Color fundus photograph — 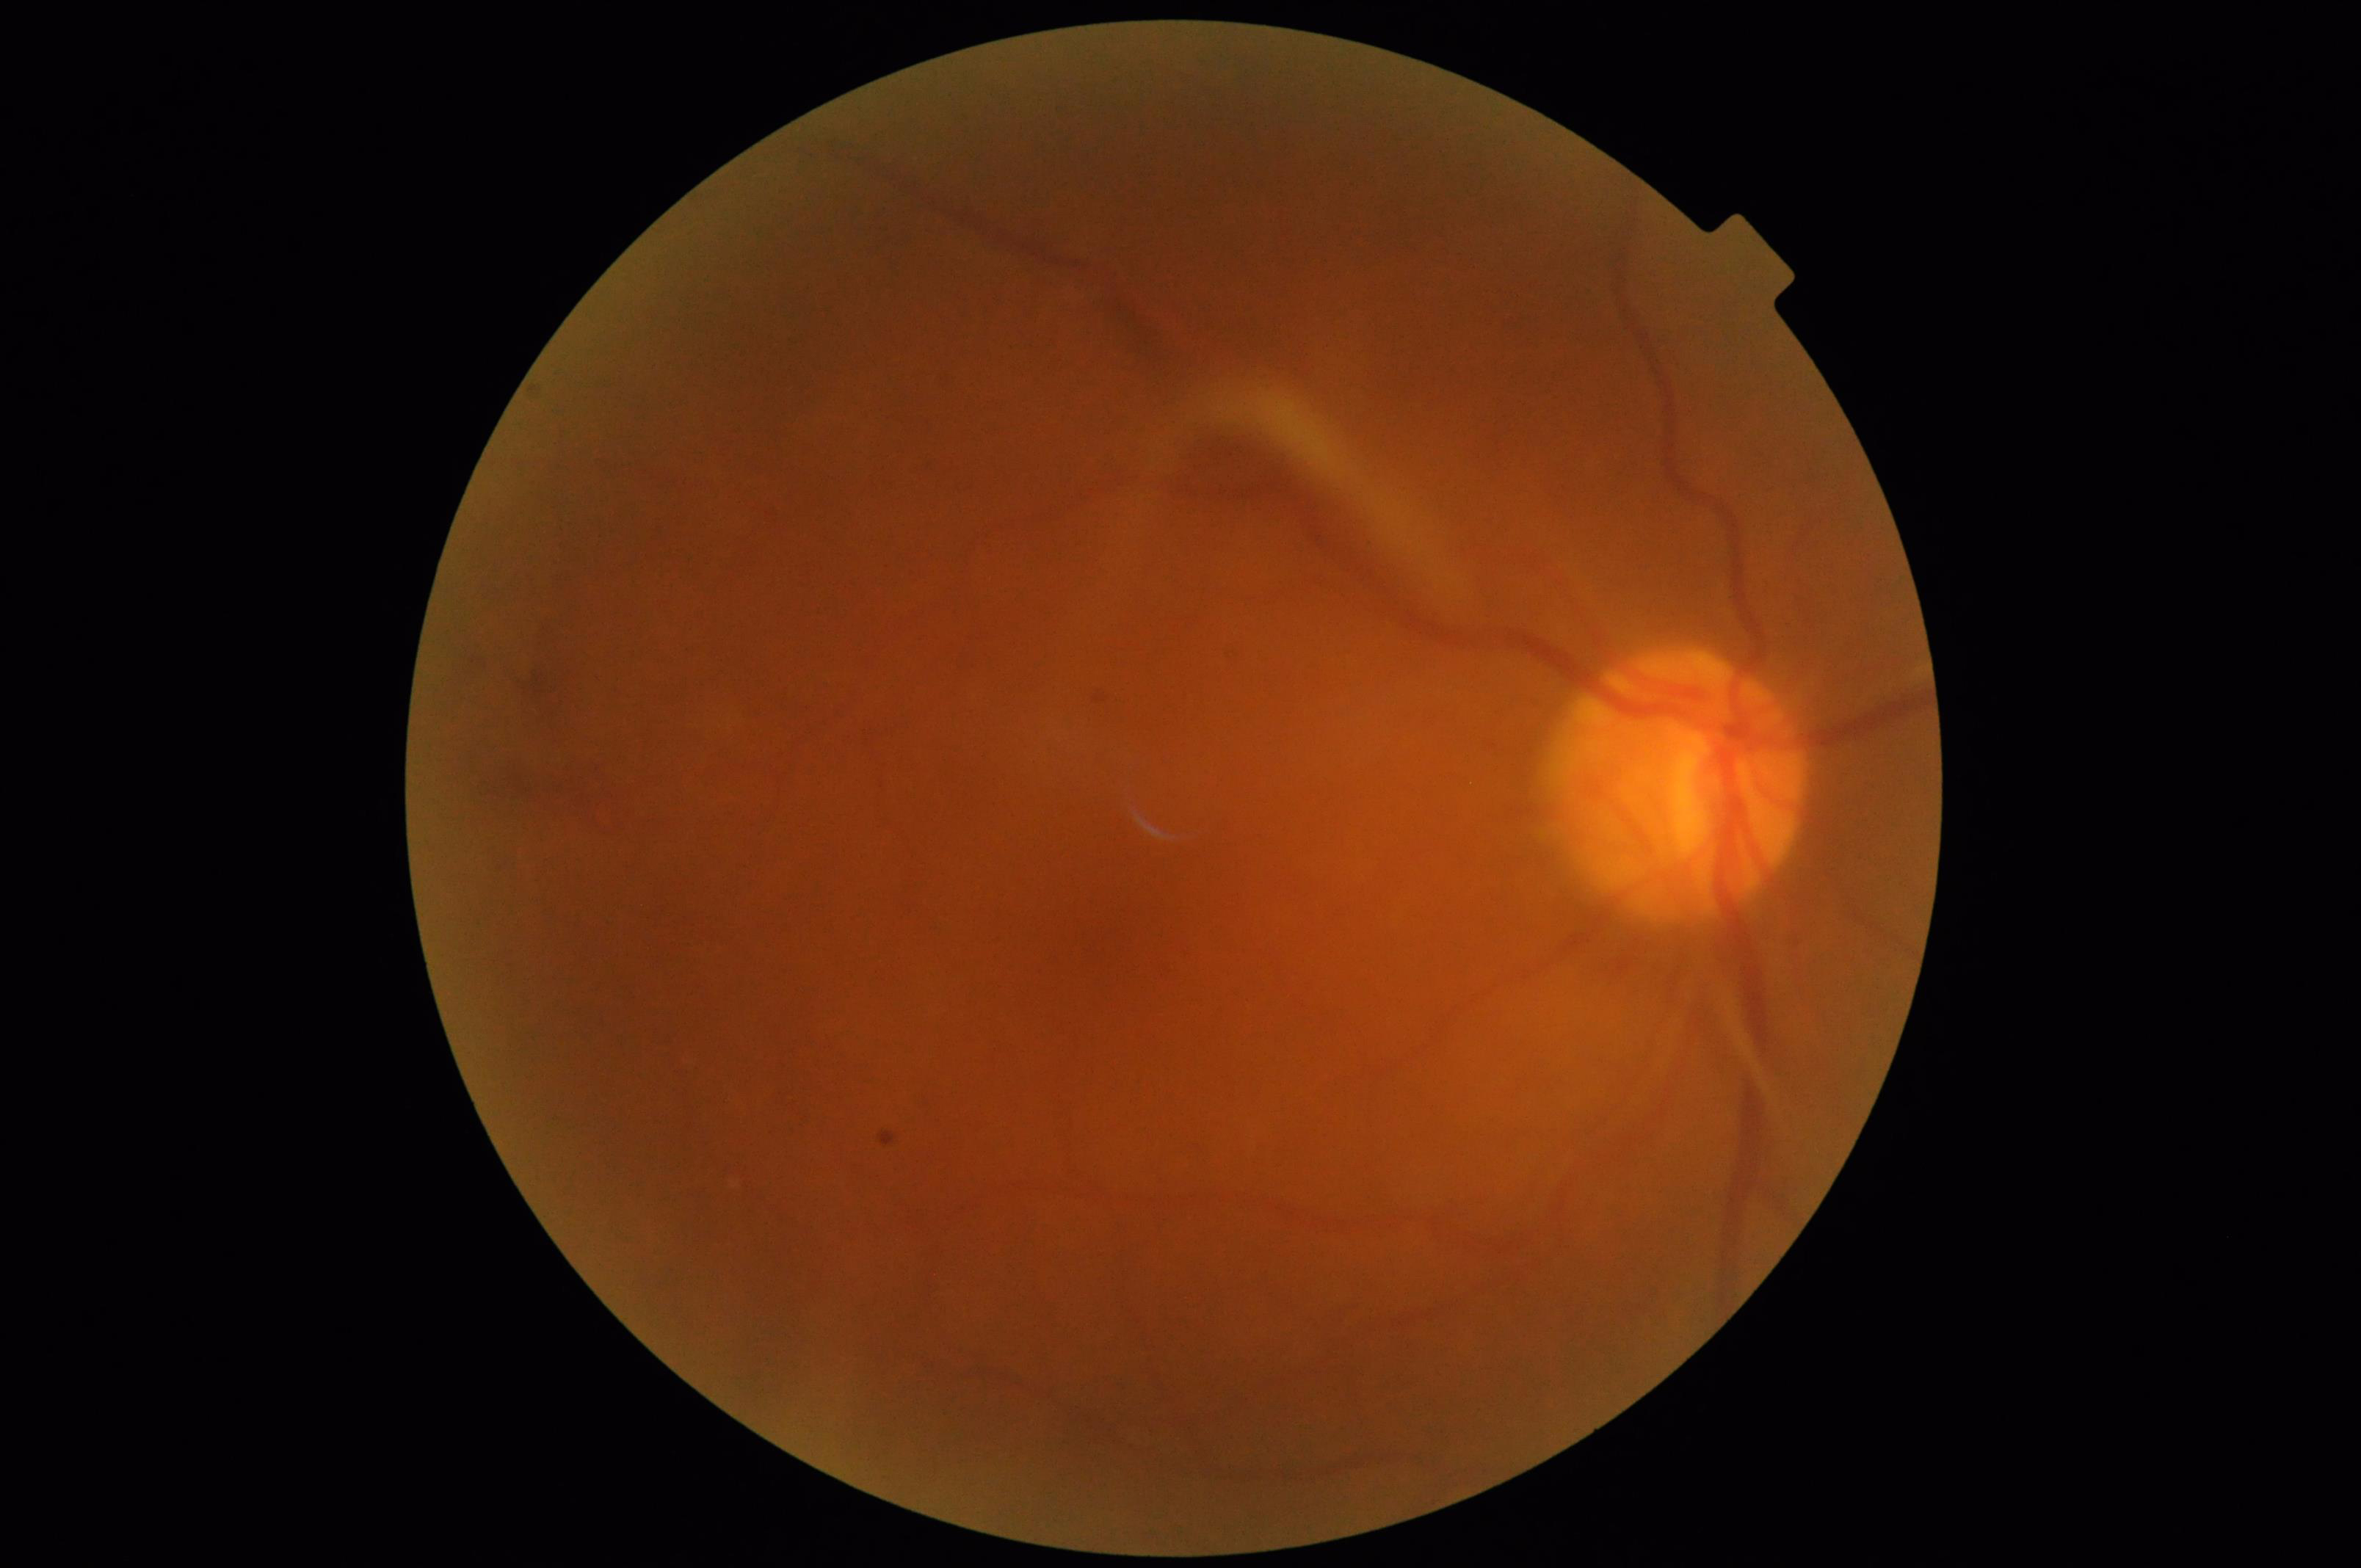

Sharpness = blurry | Illumination/color = satisfactory | Overall image quality = poor | Contrast = reduced.